Color fundus image
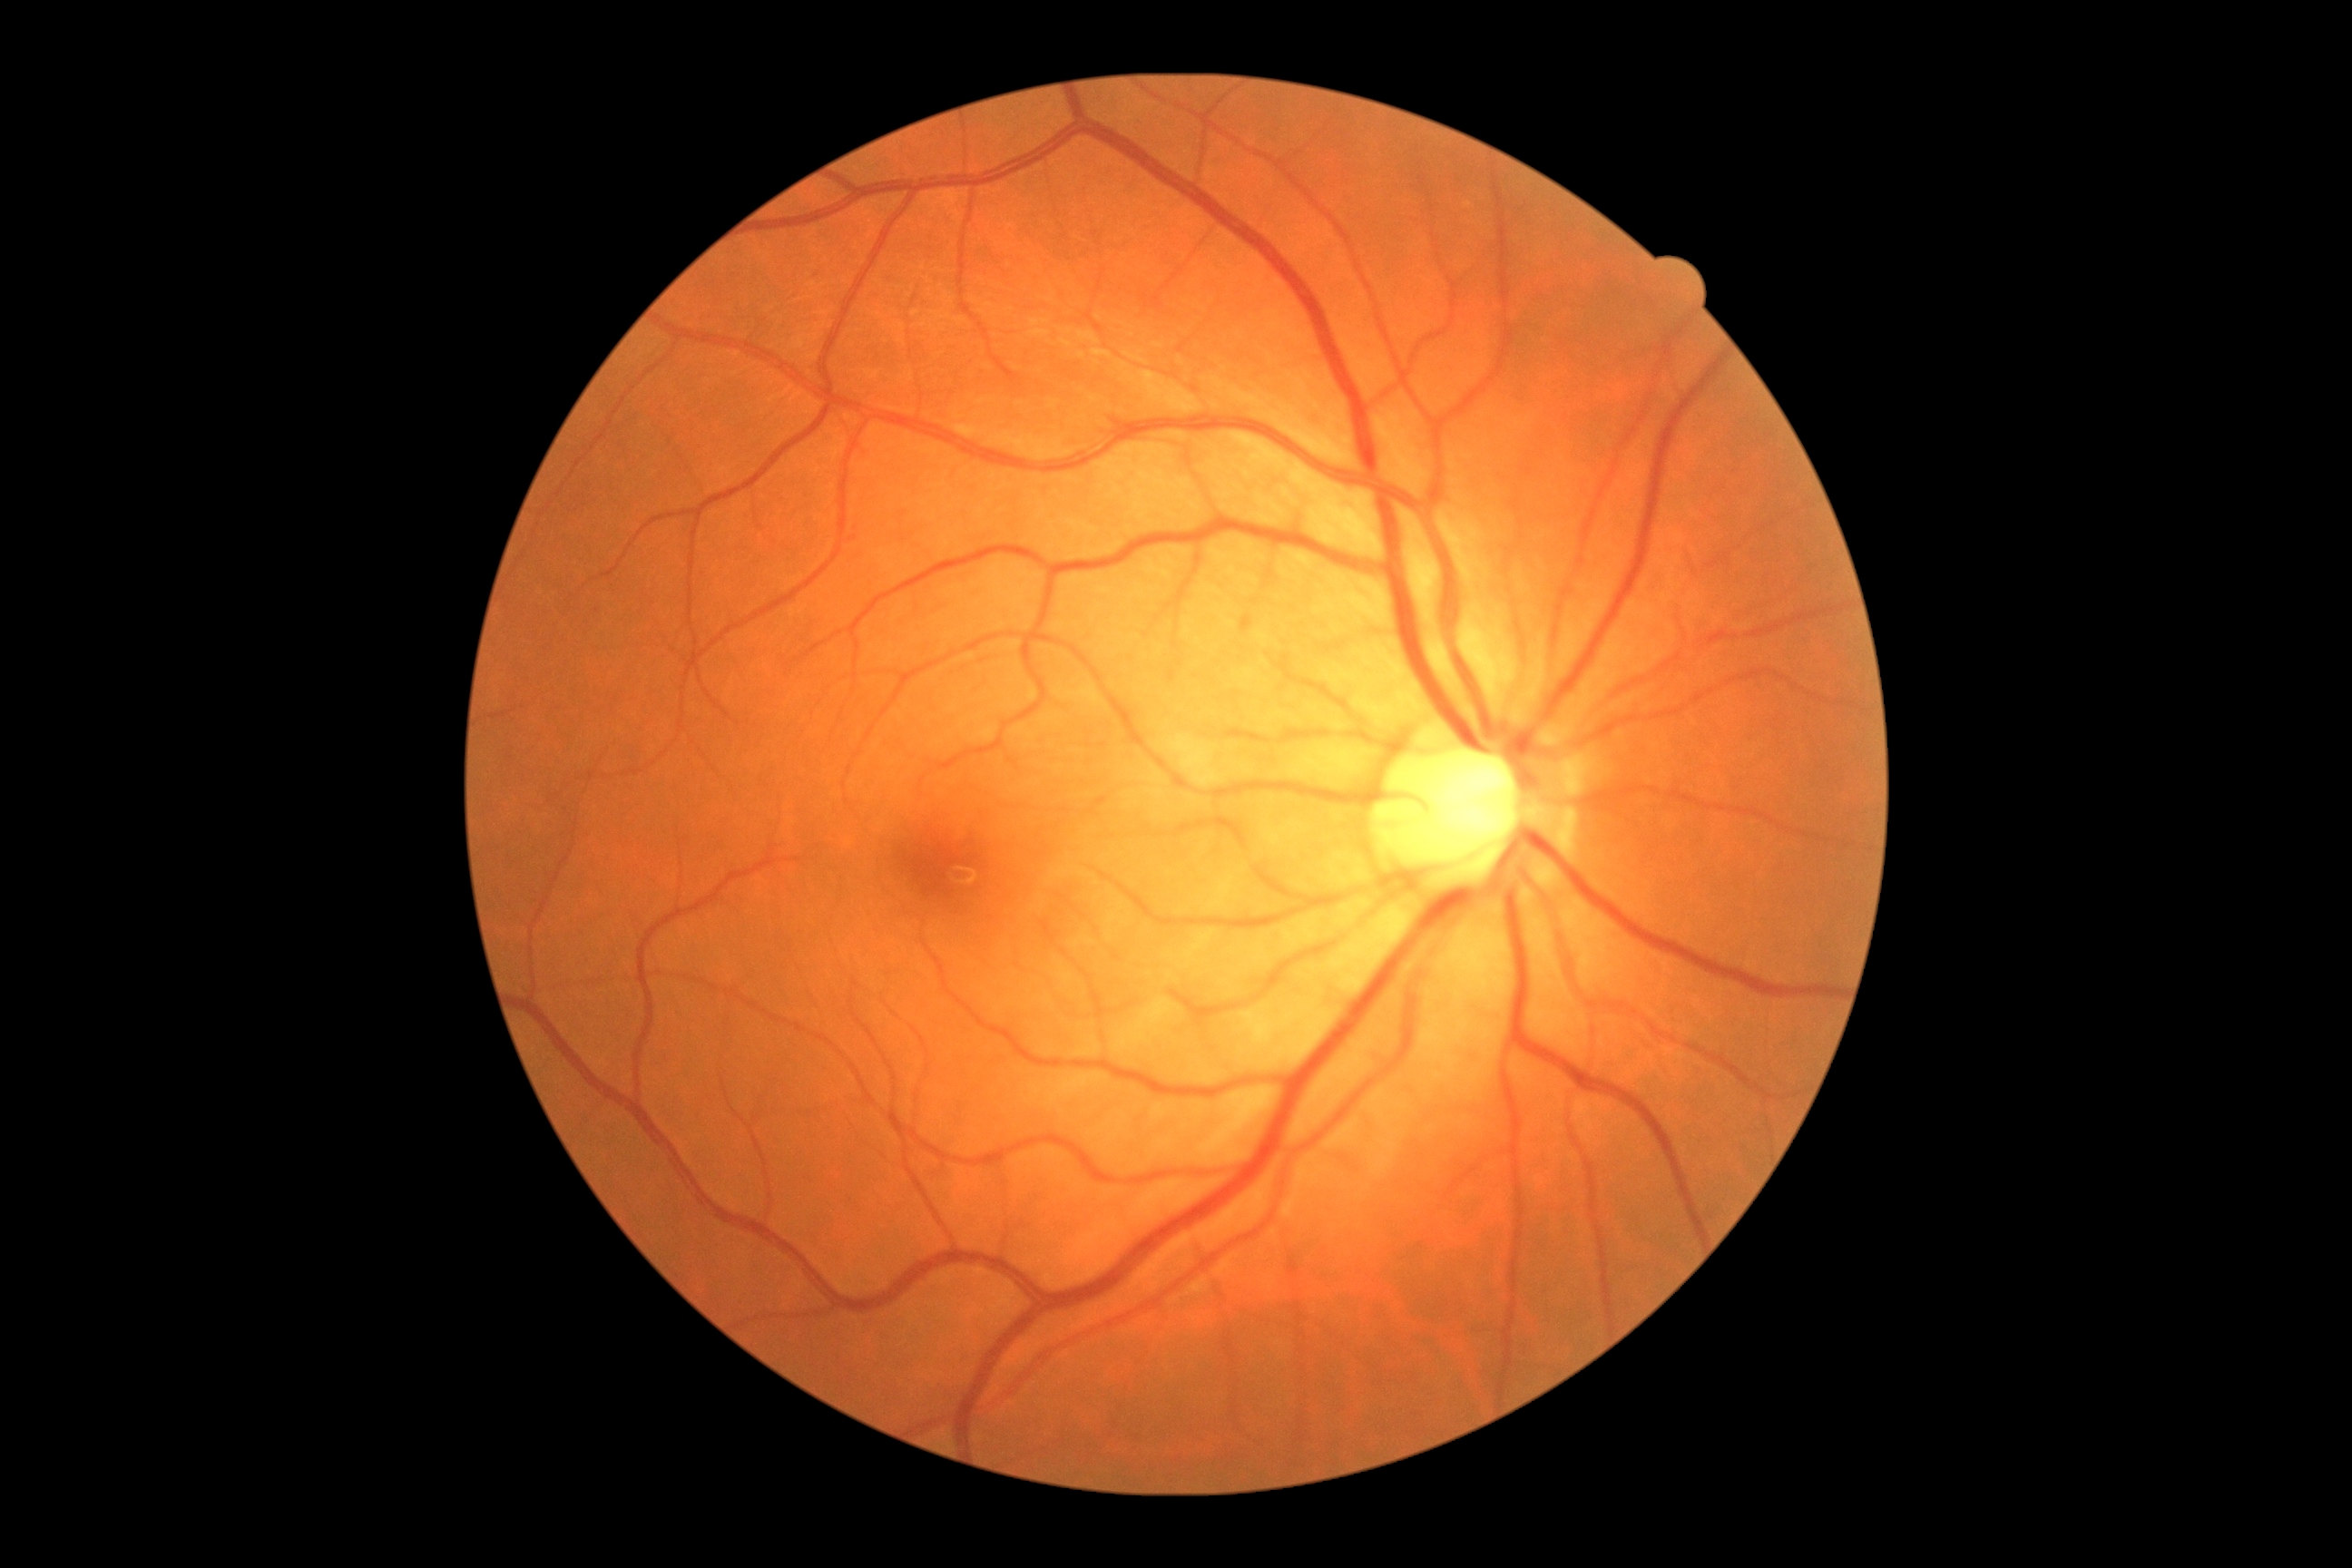 DR severity: 0/4.